Camera: NIDEK AFC-230. 45 degree fundus photograph. Graded on the modified Davis scale. Nonmydriatic fundus photograph.
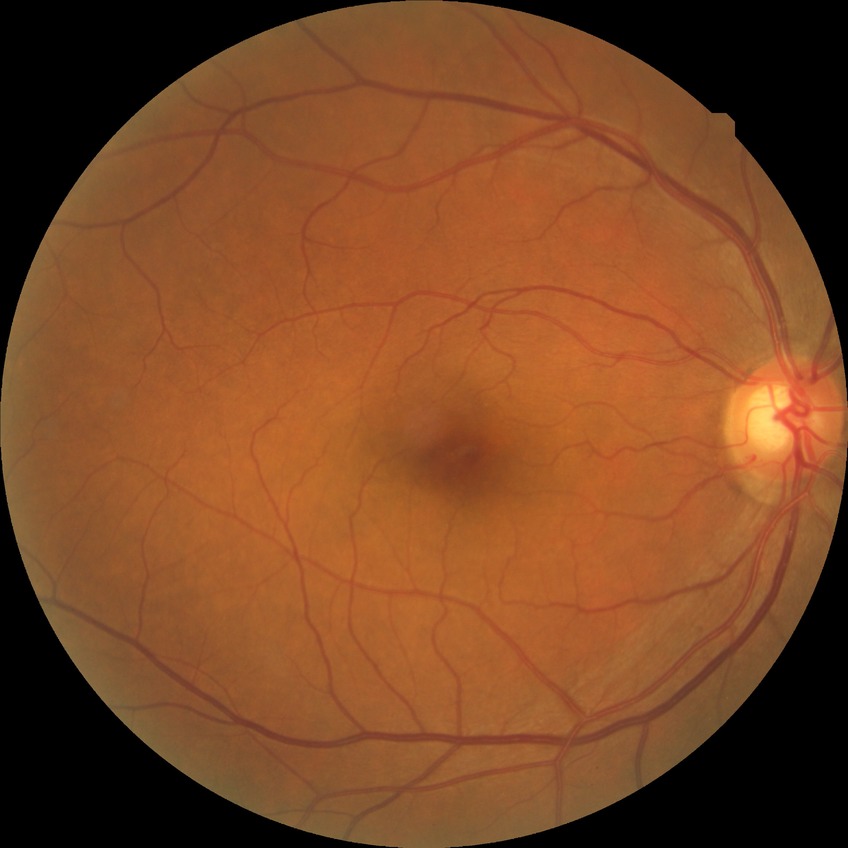

retinopathy stage = no diabetic retinopathy